848x848px
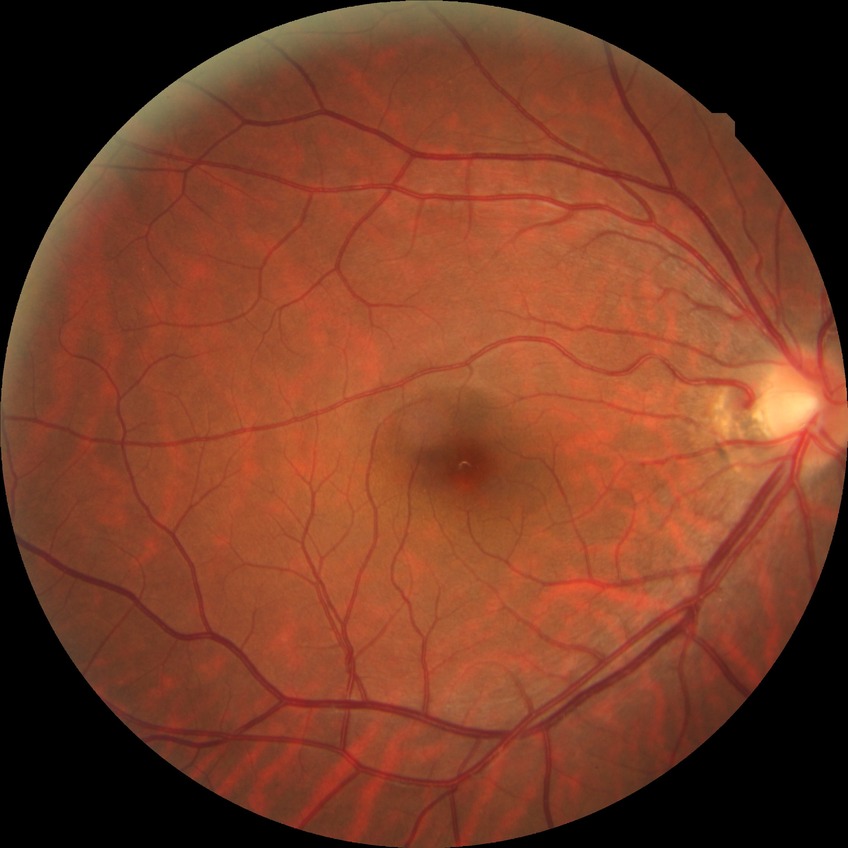 Annotations:
• diabetic retinopathy (DR): no diabetic retinopathy (NDR)